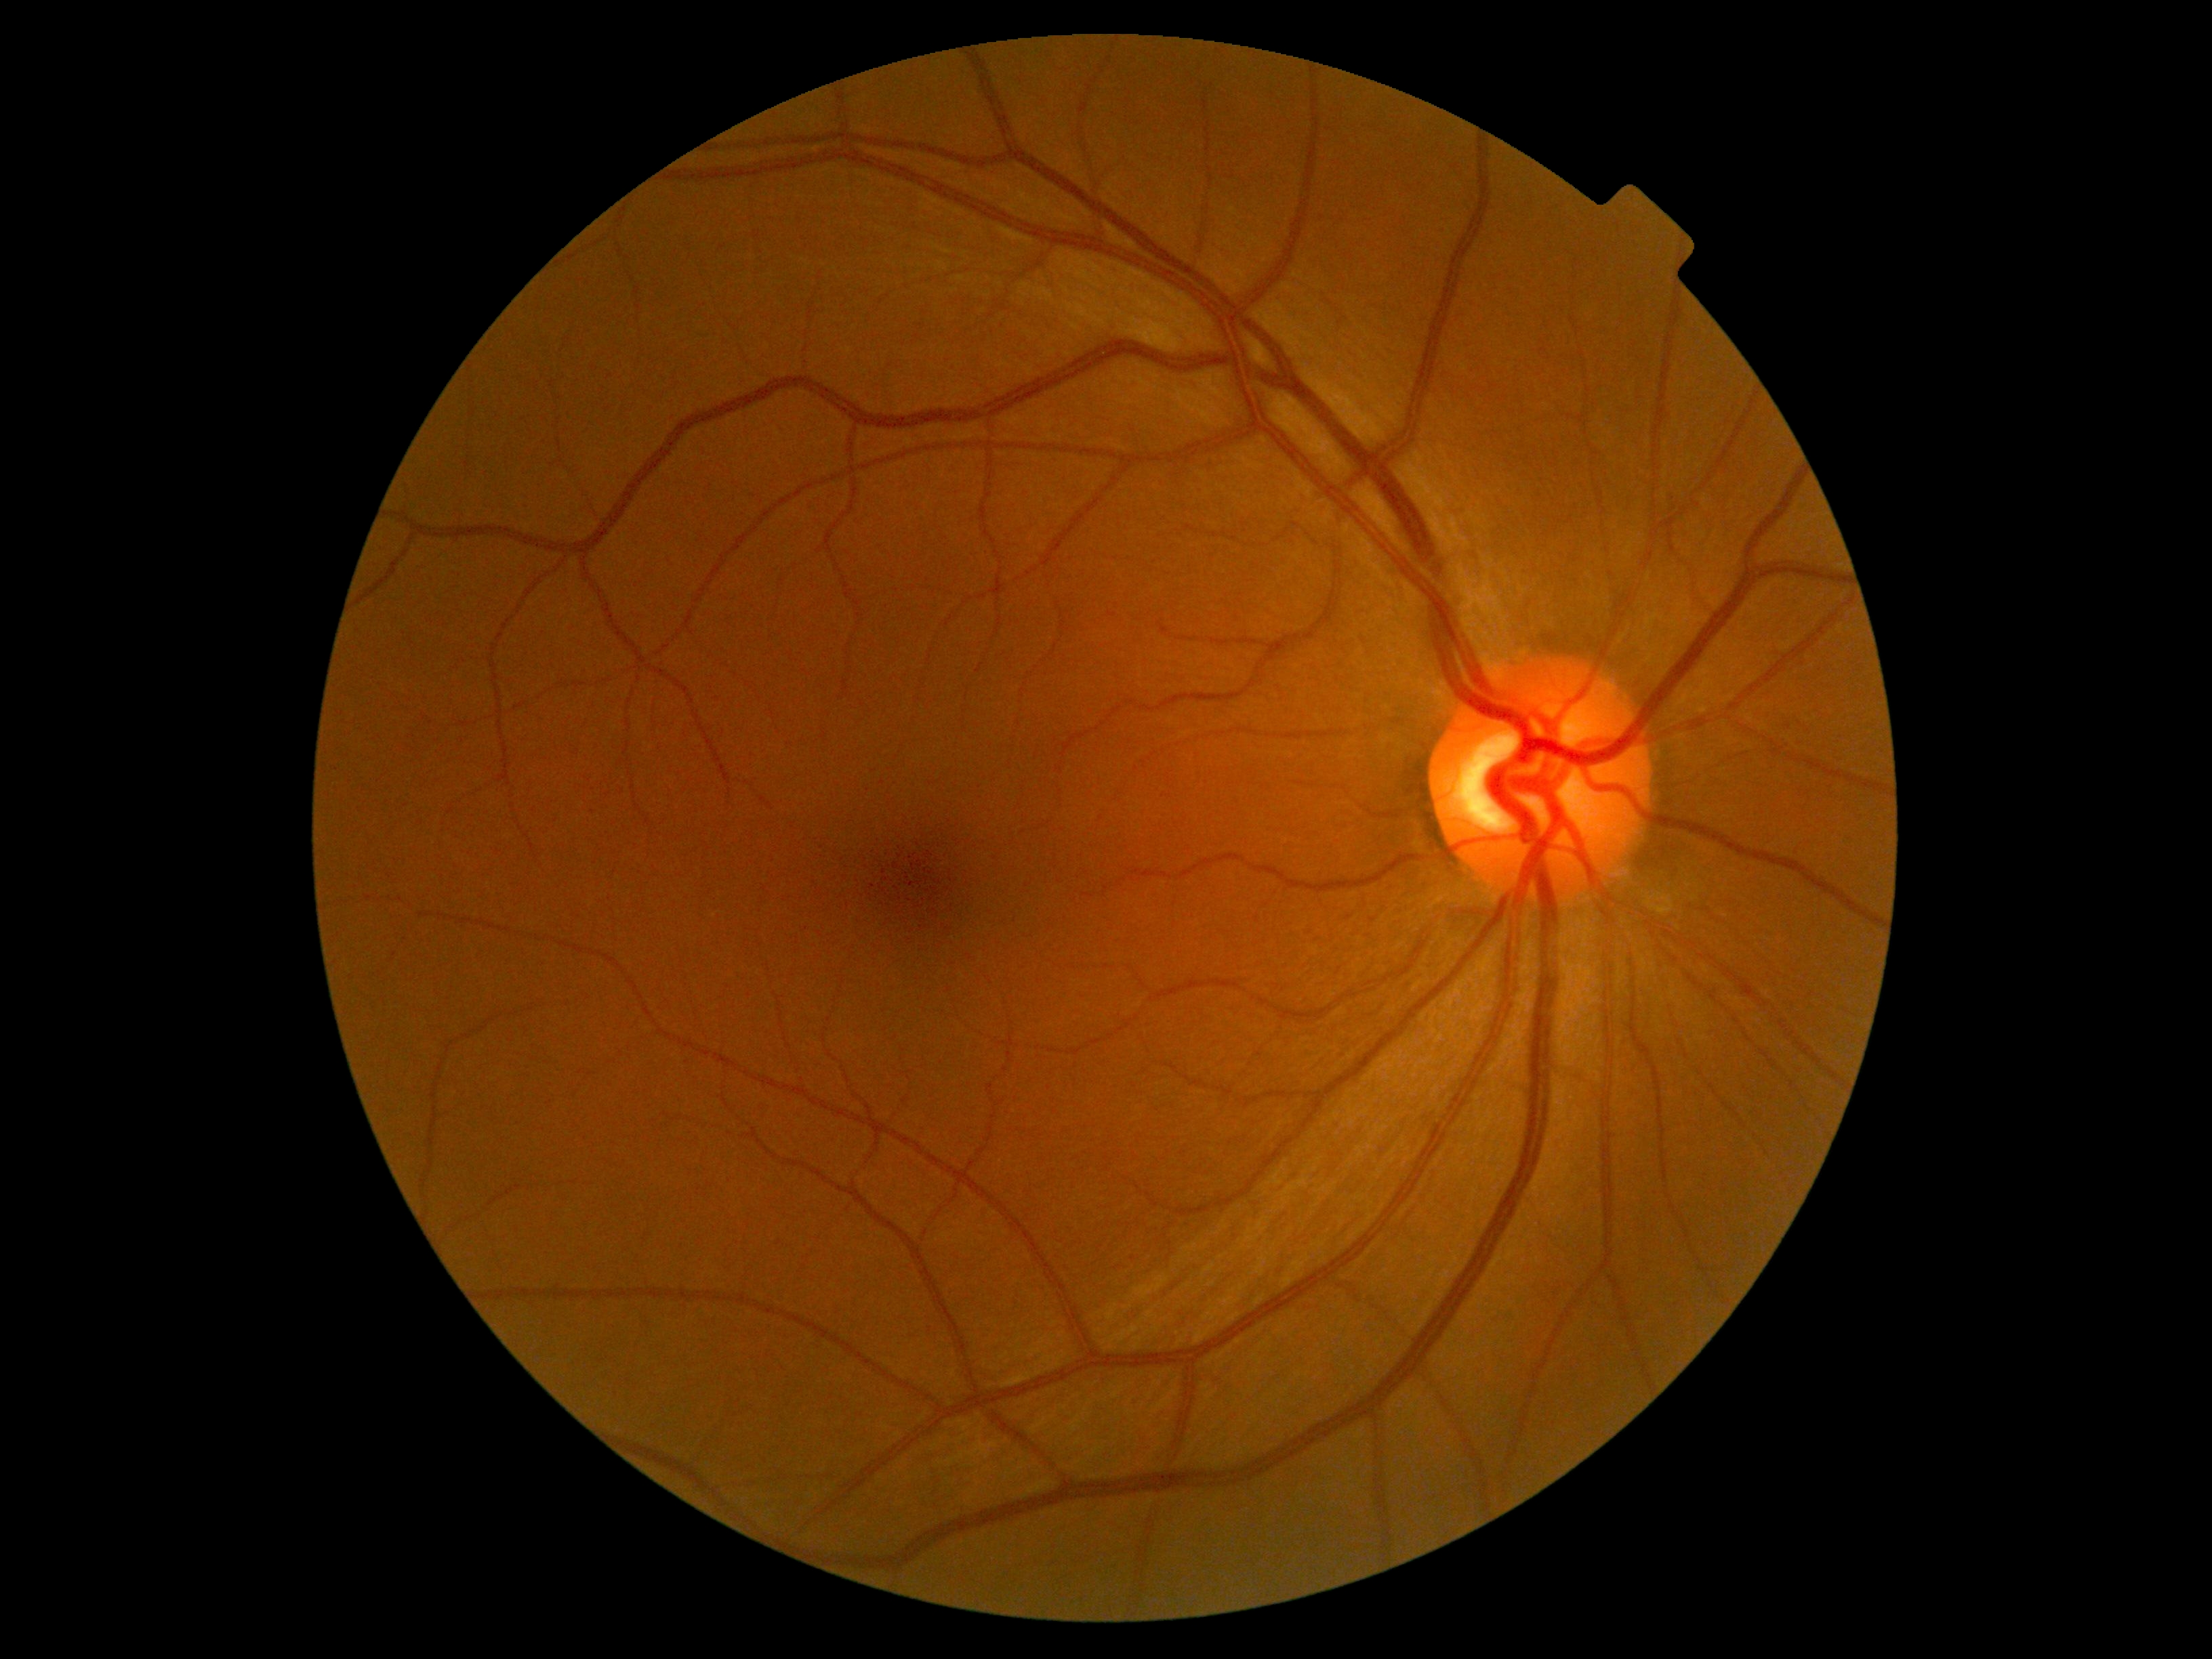 diabetic retinopathy severity = grade 0 (no apparent retinopathy) — no visible signs of diabetic retinopathy | DR impression = no DR findings.